Clarity RetCam 3, 130° FOV · wide-field fundus photograph from neonatal ROP screening · 640x480px: 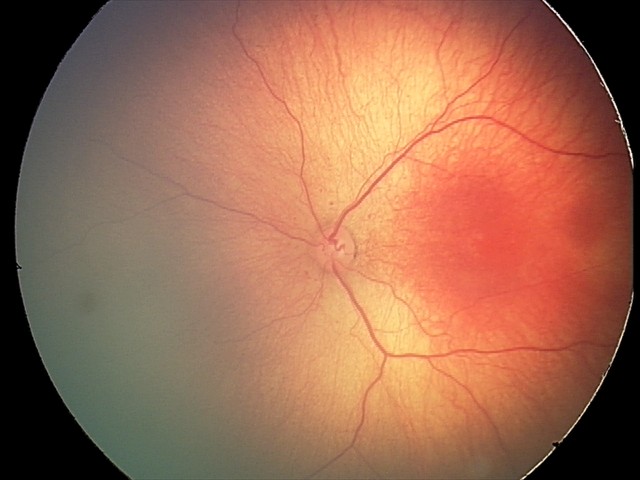
Screening diagnosis = retinopathy of prematurity (ROP) stage 2
plus form = absent